Wide-field contact fundus photograph of an infant:
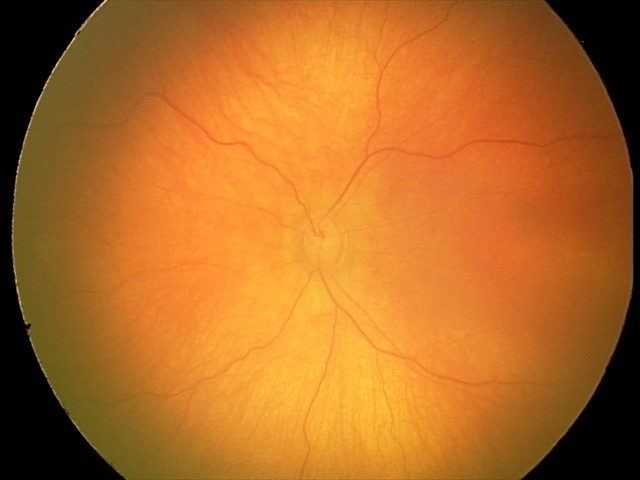 Diagnosis: physiological.